Color fundus photograph. 45-degree field of view:
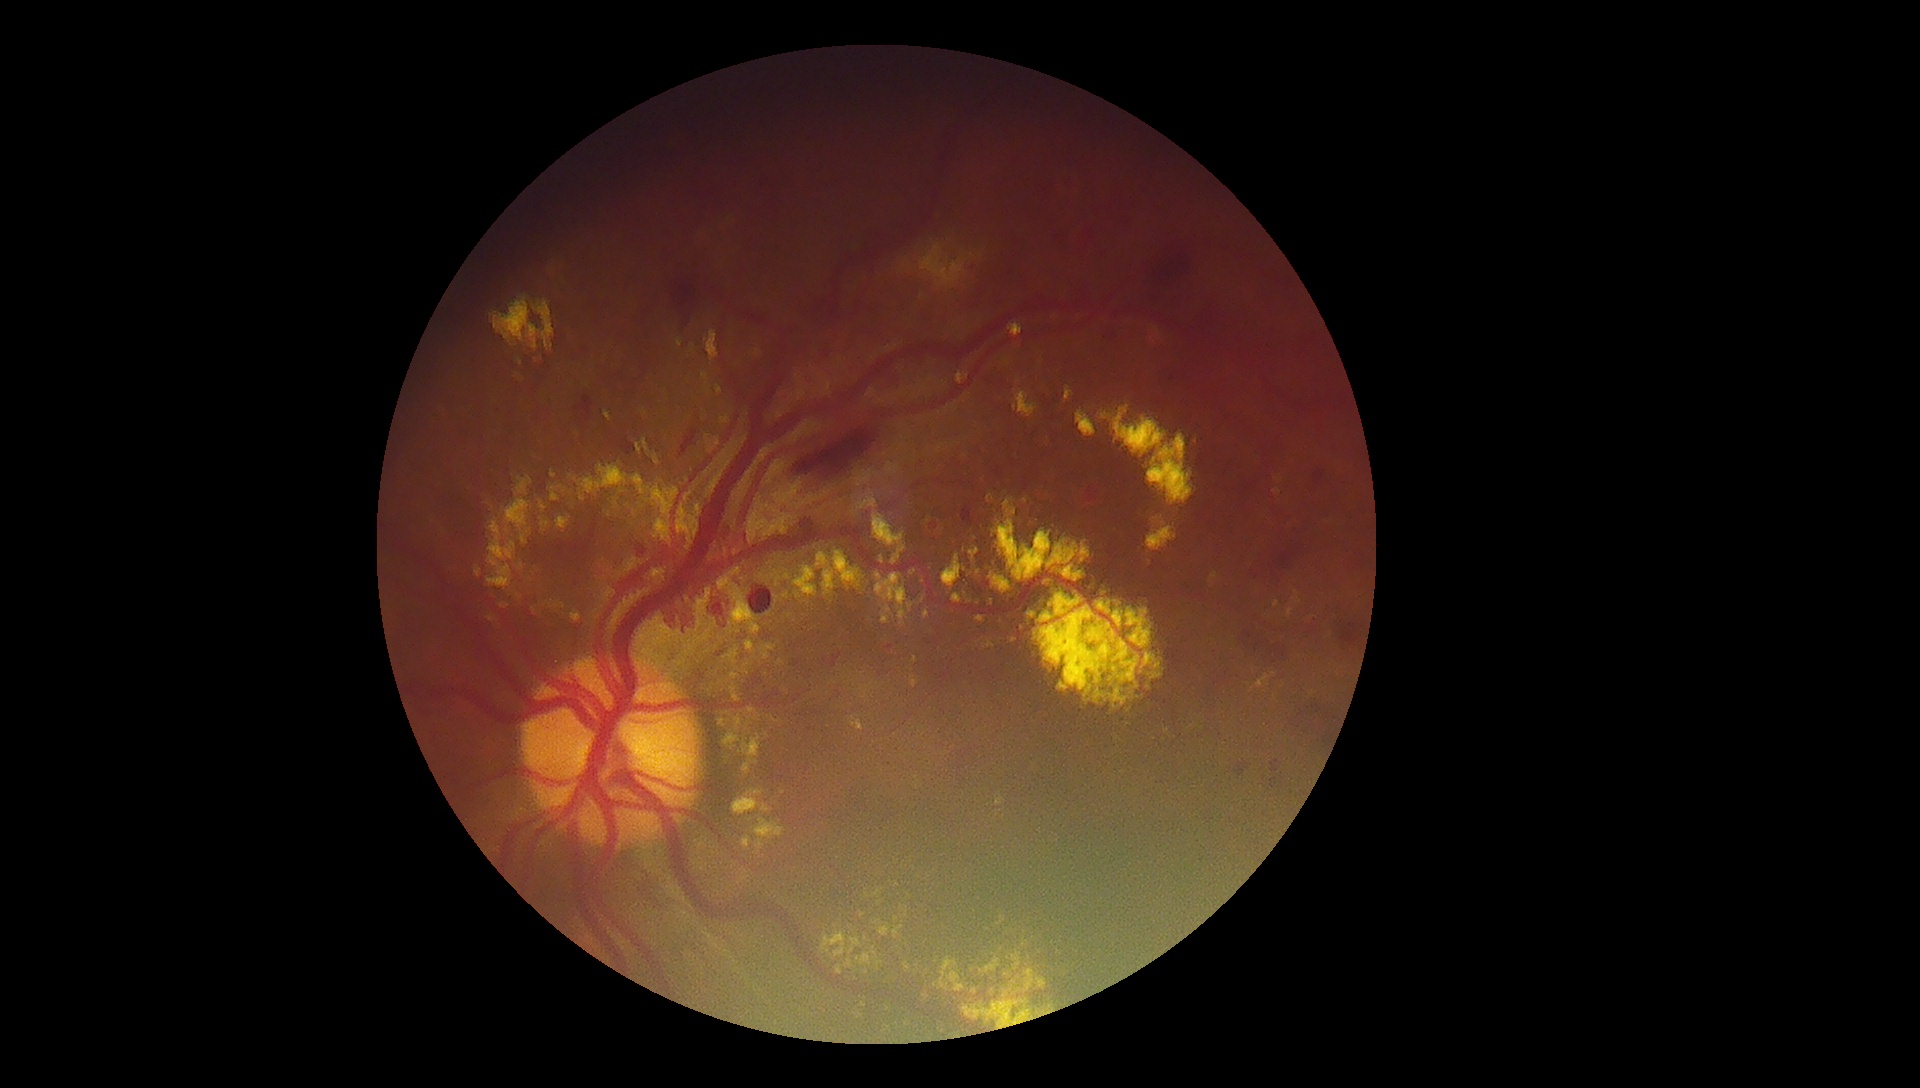

DR stage is grade 4 (PDR)
Lesions identified (partial list):
- MAs: [left=1198, top=594, right=1207, bottom=604], [left=1271, top=760, right=1283, bottom=774], [left=821, top=651, right=844, bottom=669], [left=1234, top=760, right=1251, bottom=777], [left=745, top=671, right=764, bottom=692], [left=636, top=542, right=649, bottom=558], [left=962, top=506, right=976, bottom=527], [left=1306, top=624, right=1318, bottom=639]
- HEs (partial): [left=1333, top=618, right=1364, bottom=668], [left=1146, top=248, right=1195, bottom=293], [left=672, top=278, right=699, bottom=315], [left=1237, top=627, right=1290, bottom=670], [left=1314, top=469, right=1326, bottom=485], [left=875, top=364, right=905, bottom=394], [left=785, top=401, right=898, bottom=489], [left=611, top=438, right=636, bottom=458], [left=800, top=519, right=818, bottom=532], [left=683, top=314, right=692, bottom=331], [left=1288, top=701, right=1340, bottom=750], [left=679, top=426, right=701, bottom=460], [left=575, top=395, right=595, bottom=423], [left=749, top=586, right=774, bottom=615], [left=884, top=646, right=894, bottom=651], [left=1279, top=552, right=1296, bottom=568]
- EXs (partial): [left=705, top=435, right=721, bottom=454], [left=742, top=837, right=752, bottom=849], [left=920, top=244, right=965, bottom=283], [left=854, top=1009, right=863, bottom=1019], [left=924, top=610, right=930, bottom=619], [left=556, top=516, right=572, bottom=530], [left=993, top=490, right=1170, bottom=714], [left=677, top=504, right=701, bottom=545], [left=851, top=717, right=863, bottom=731], [left=1076, top=409, right=1097, bottom=438], [left=908, top=603, right=914, bottom=613], [left=716, top=385, right=723, bottom=396]
- EXs (small, approximate centers) near (x=688, y=548), (x=987, y=930), (x=746, y=666), (x=913, y=677), (x=965, y=594), (x=1253, y=689), (x=721, y=684)
- SEs: not present